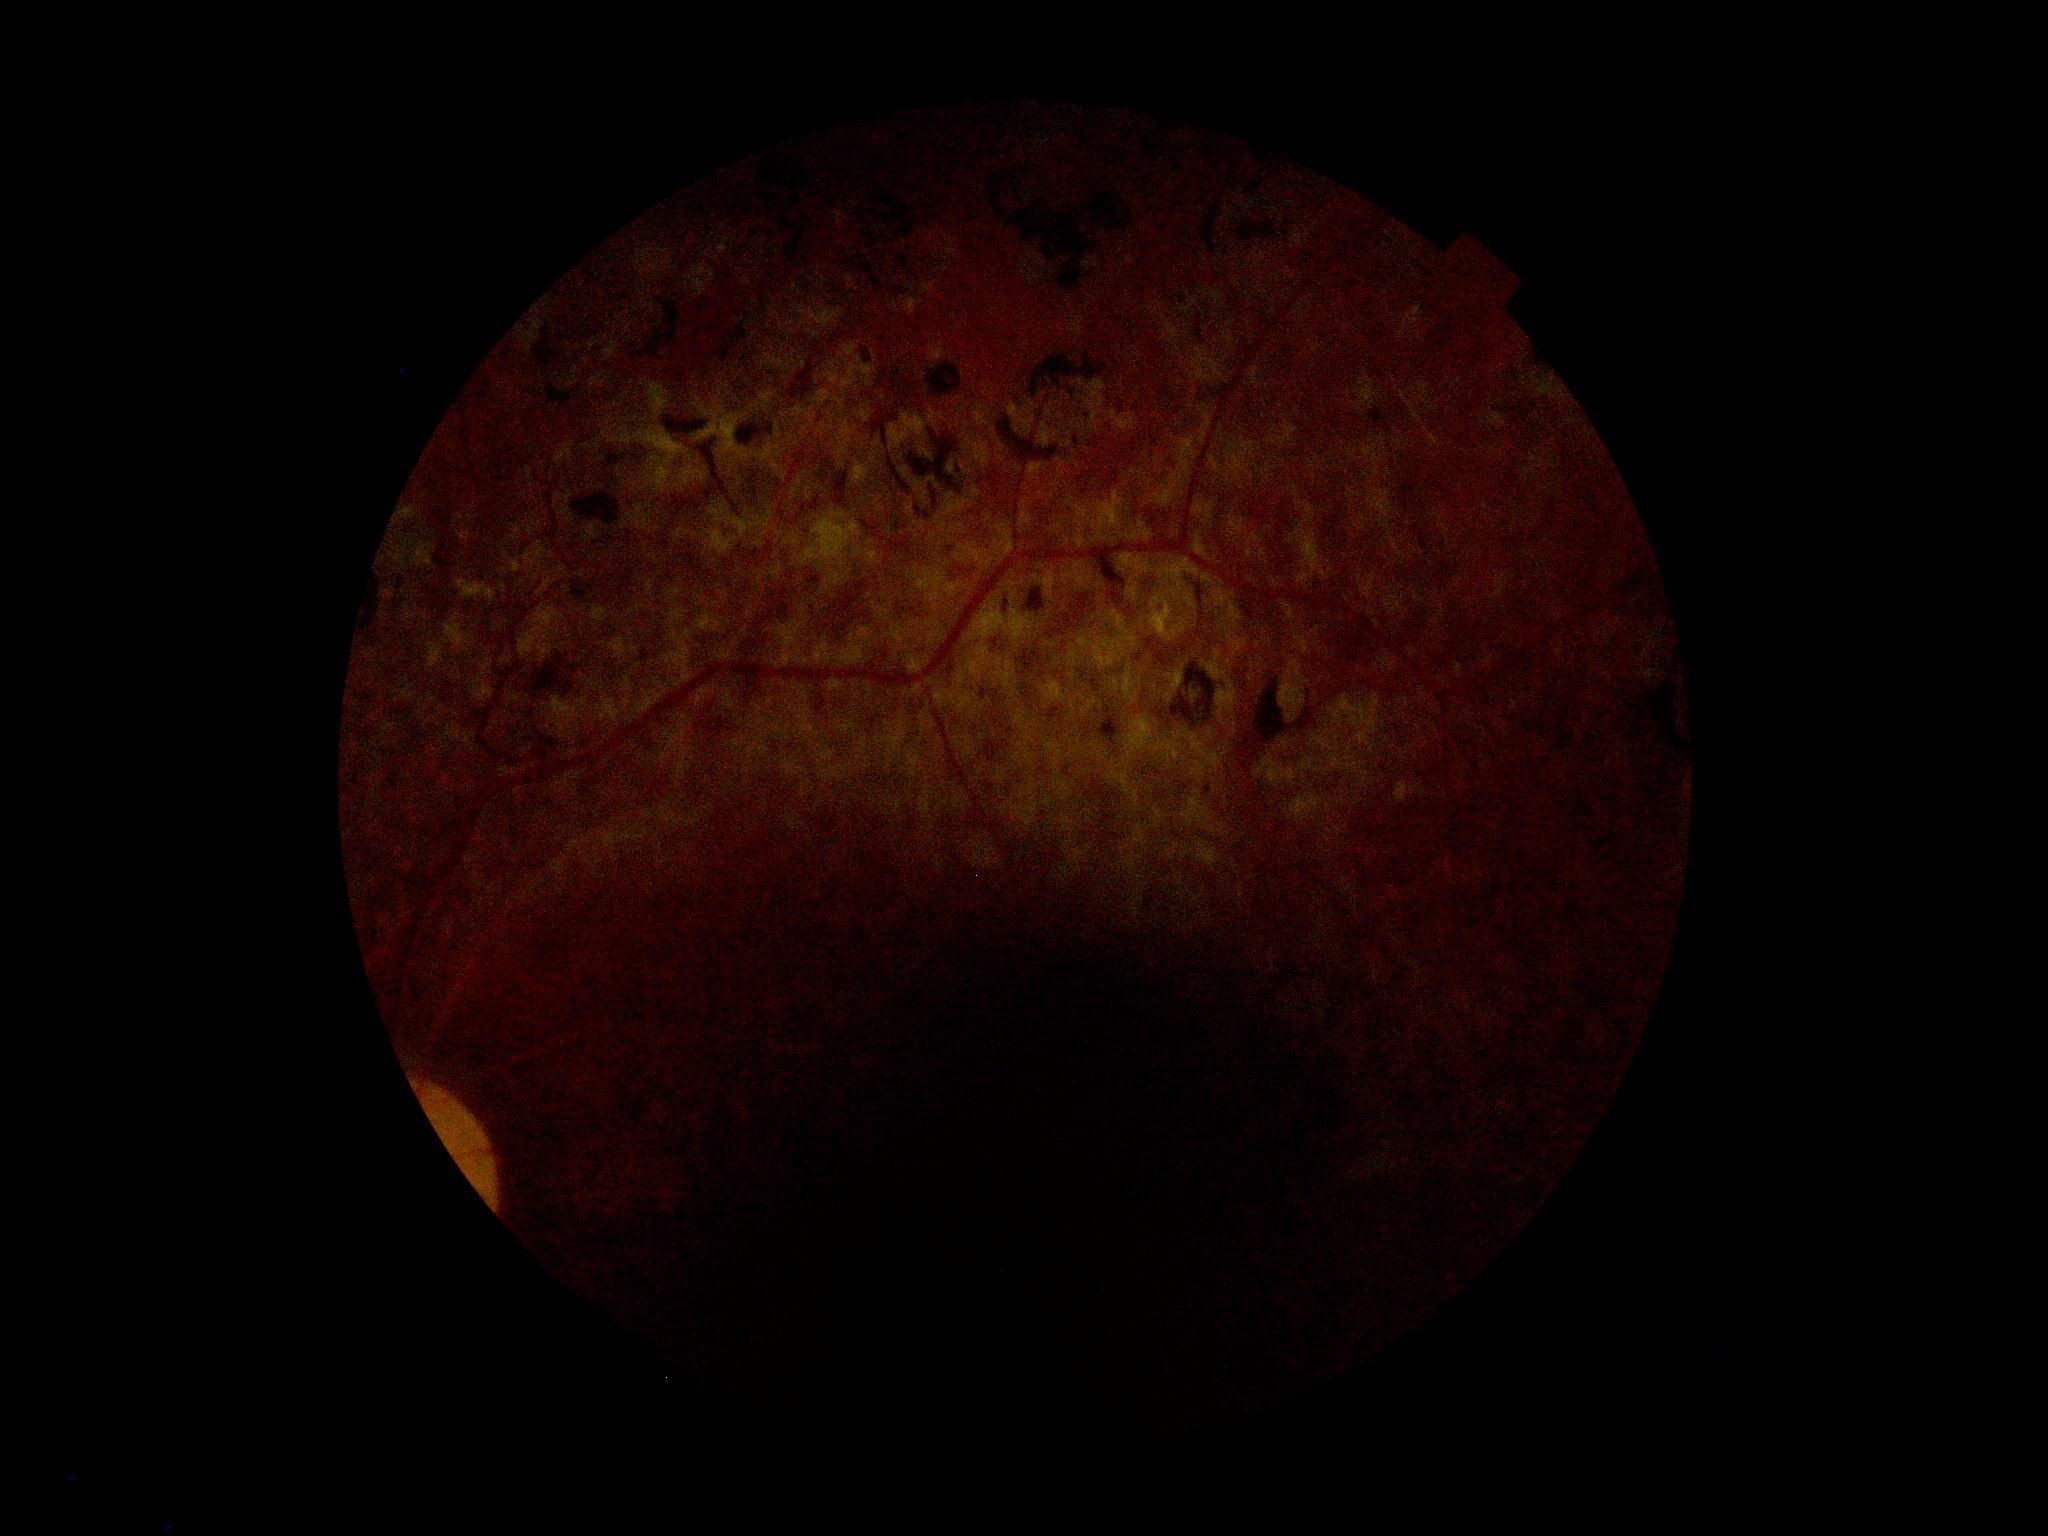 Diabetic retinopathy severity is ungradable due to poor image quality. Quality too poor to assess for DR.